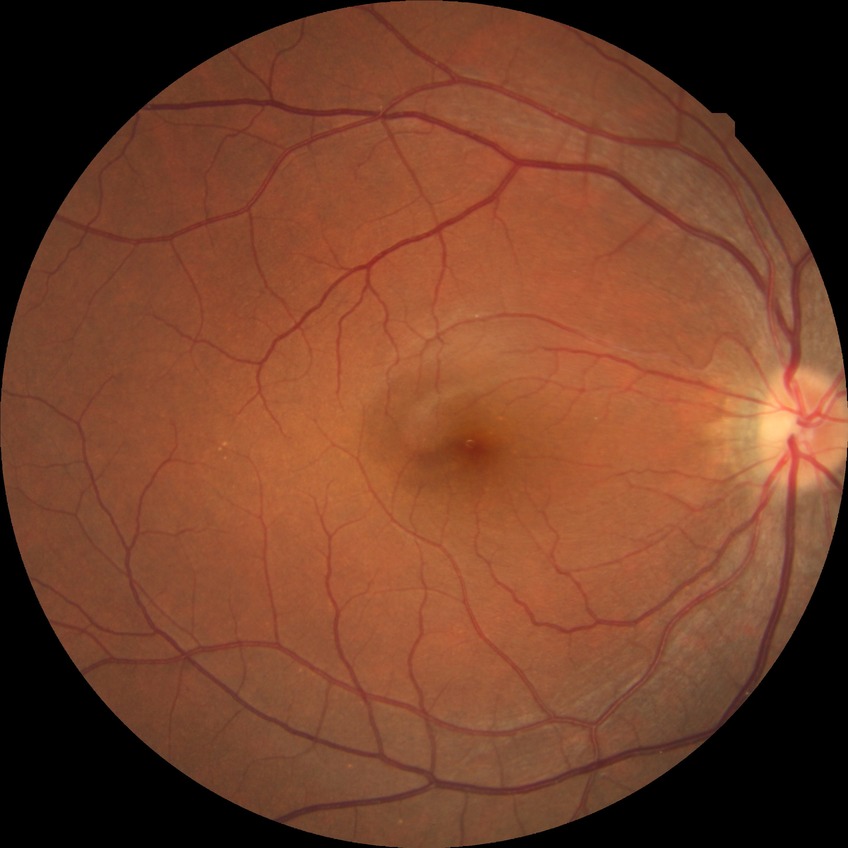 diabetic retinopathy (DR) = no diabetic retinopathy (NDR)